848 by 848 pixels; 45° field of view:
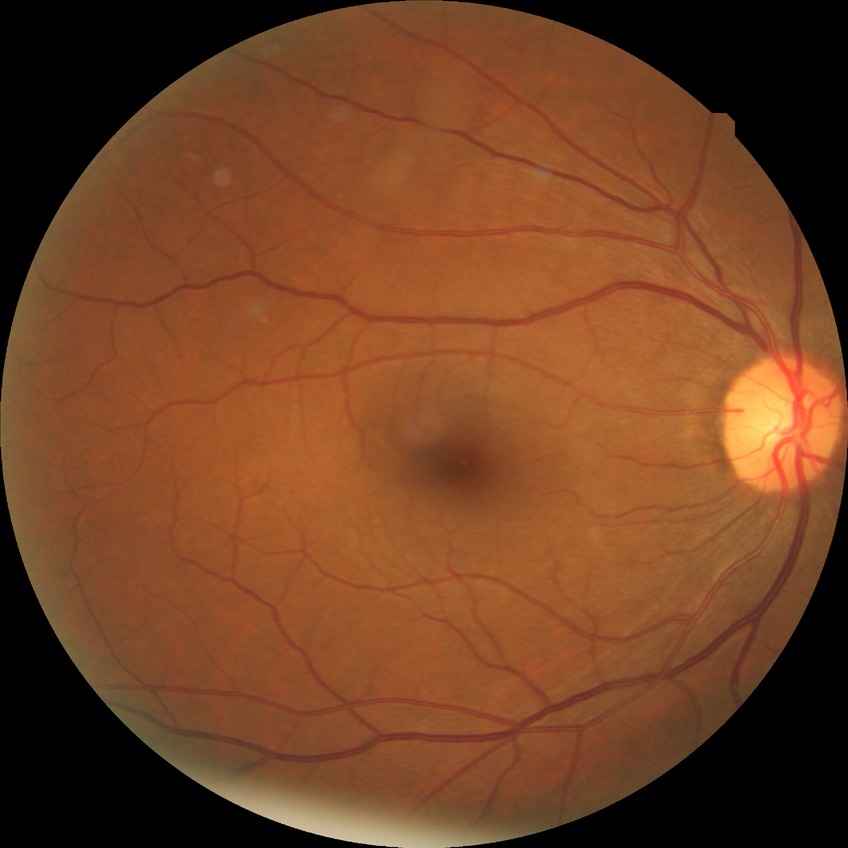 Diabetic retinopathy severity: no diabetic retinopathy.